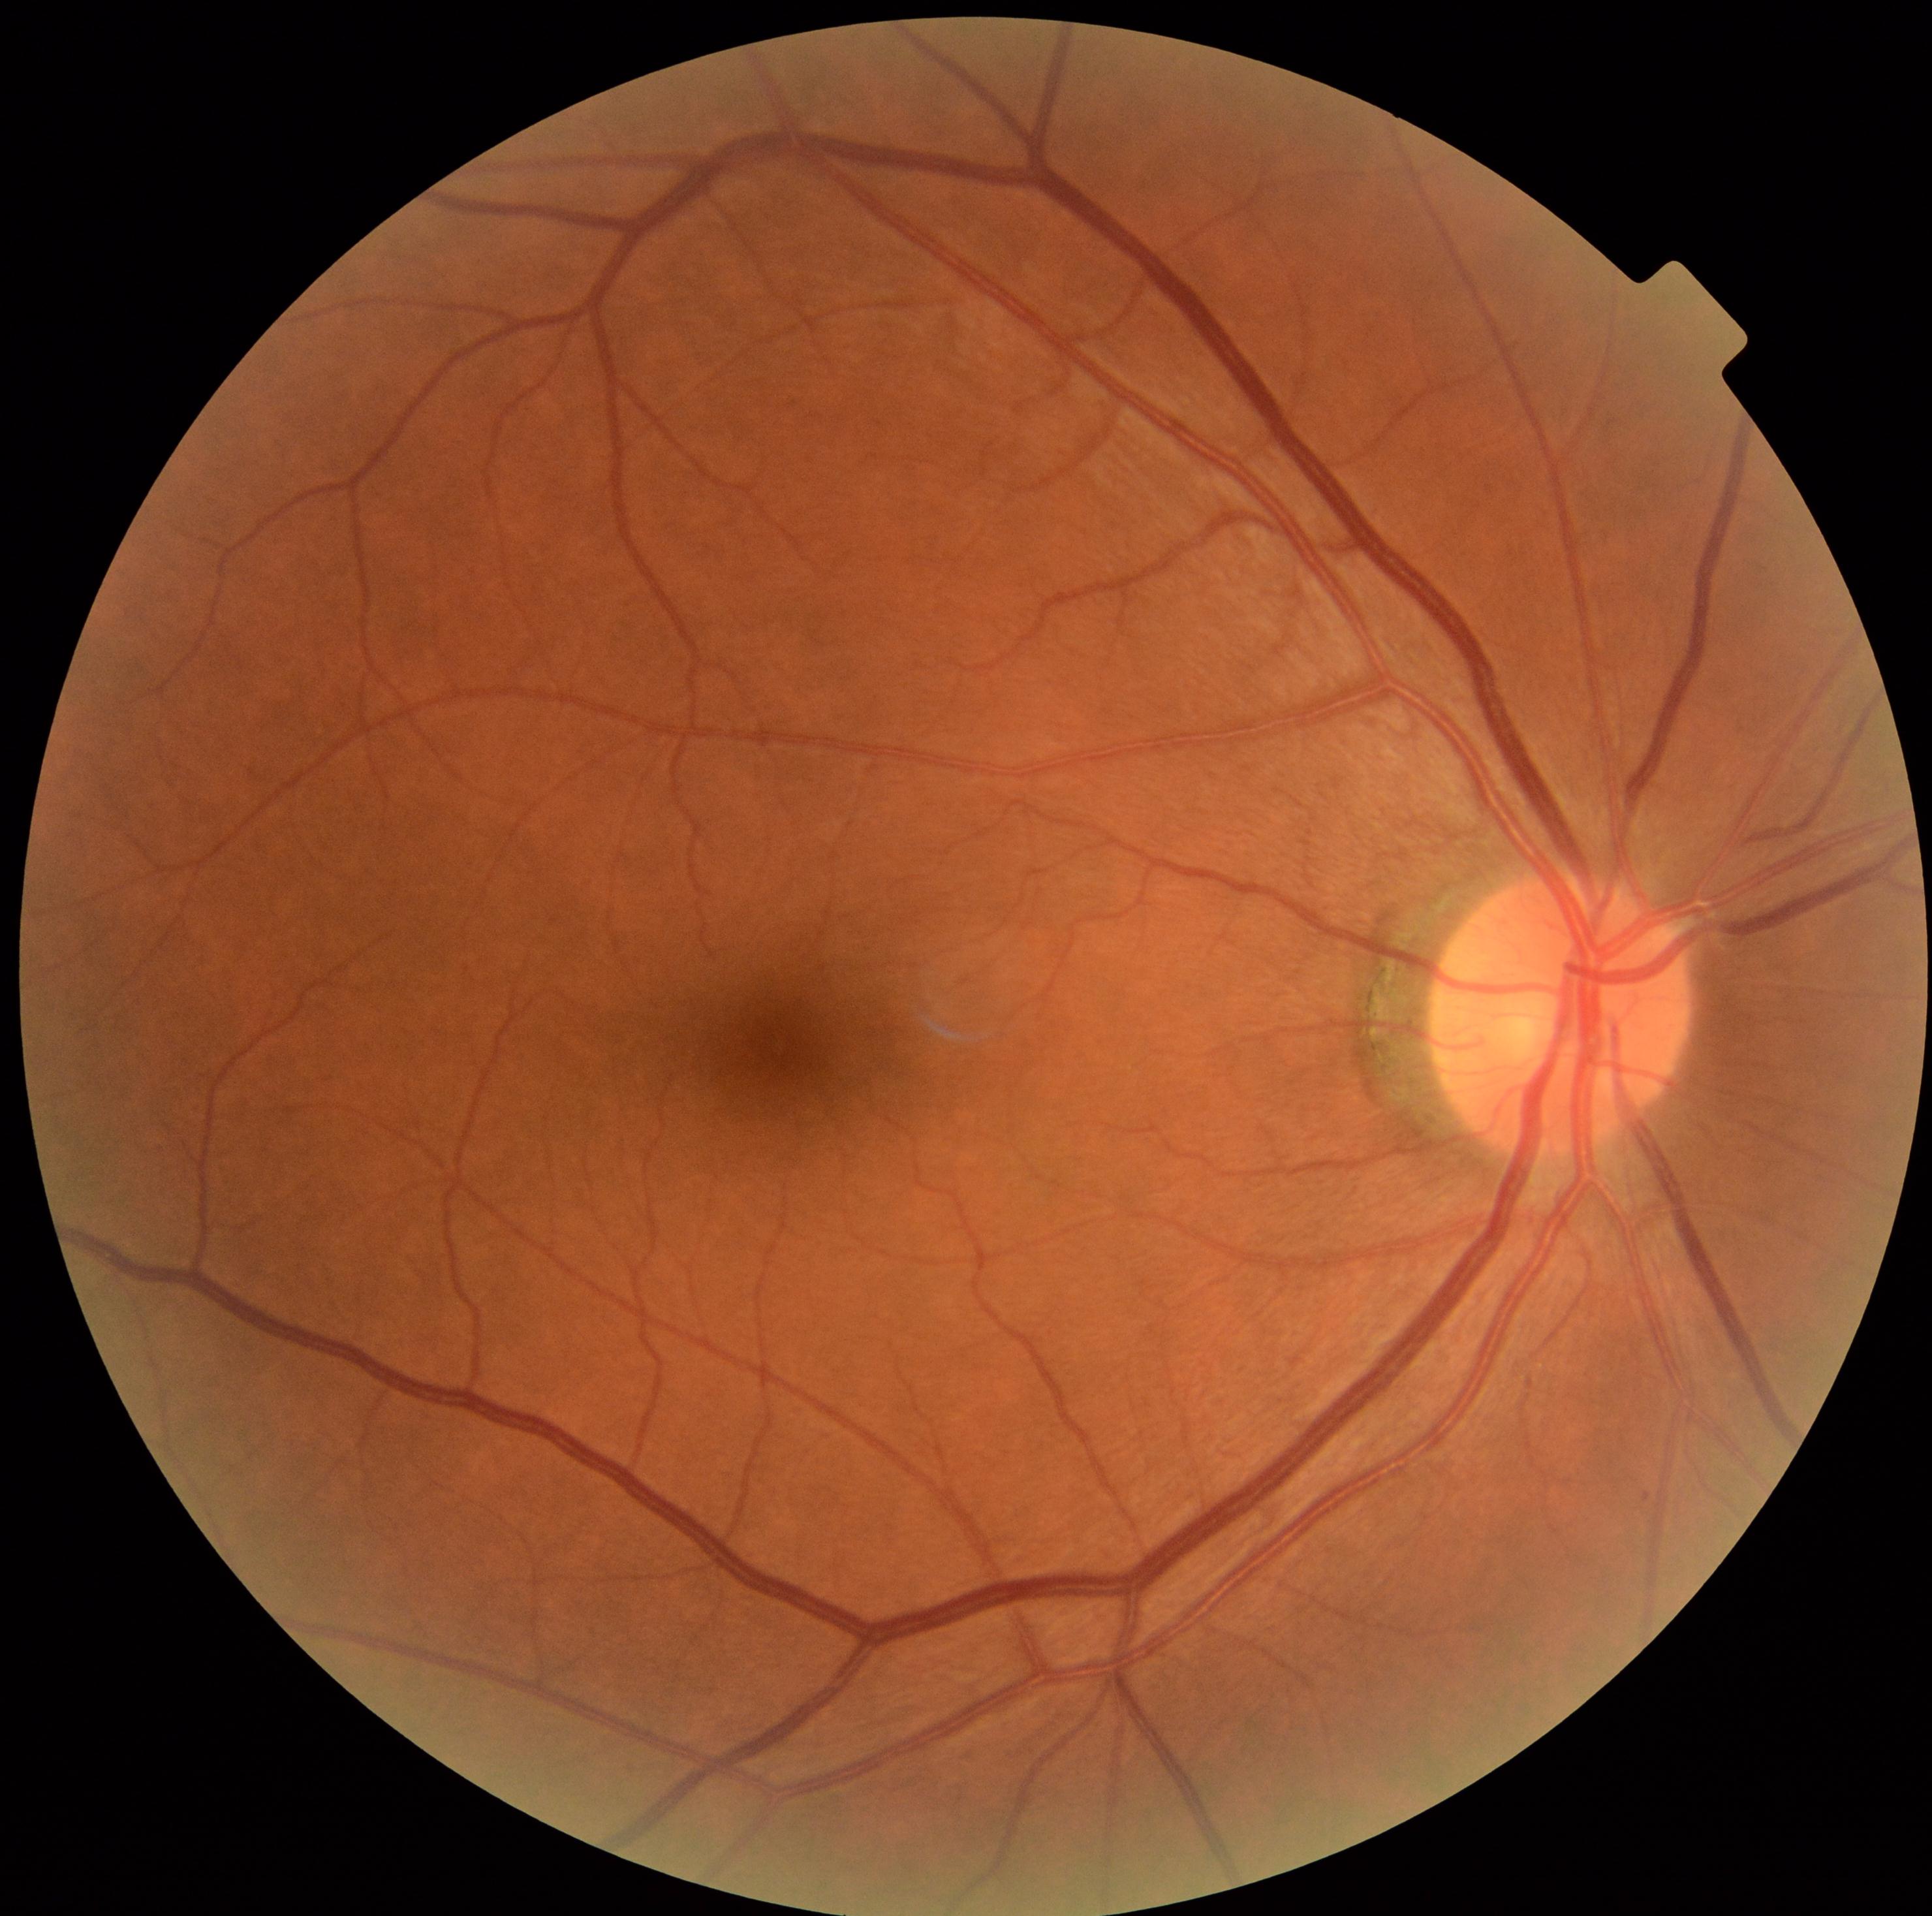

DR = 0/4.